Captured with the Clarity RetCam 3 (130° field of view) · wide-field contact fundus photograph of an infant
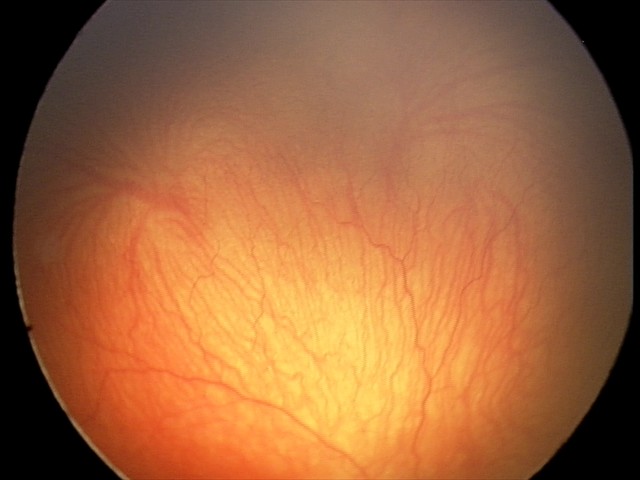

From an examination with diagnosis of A-ROP (aggressive ROP) — rapidly progressive severe ROP with prominent plus disease, often without classic stage progression.